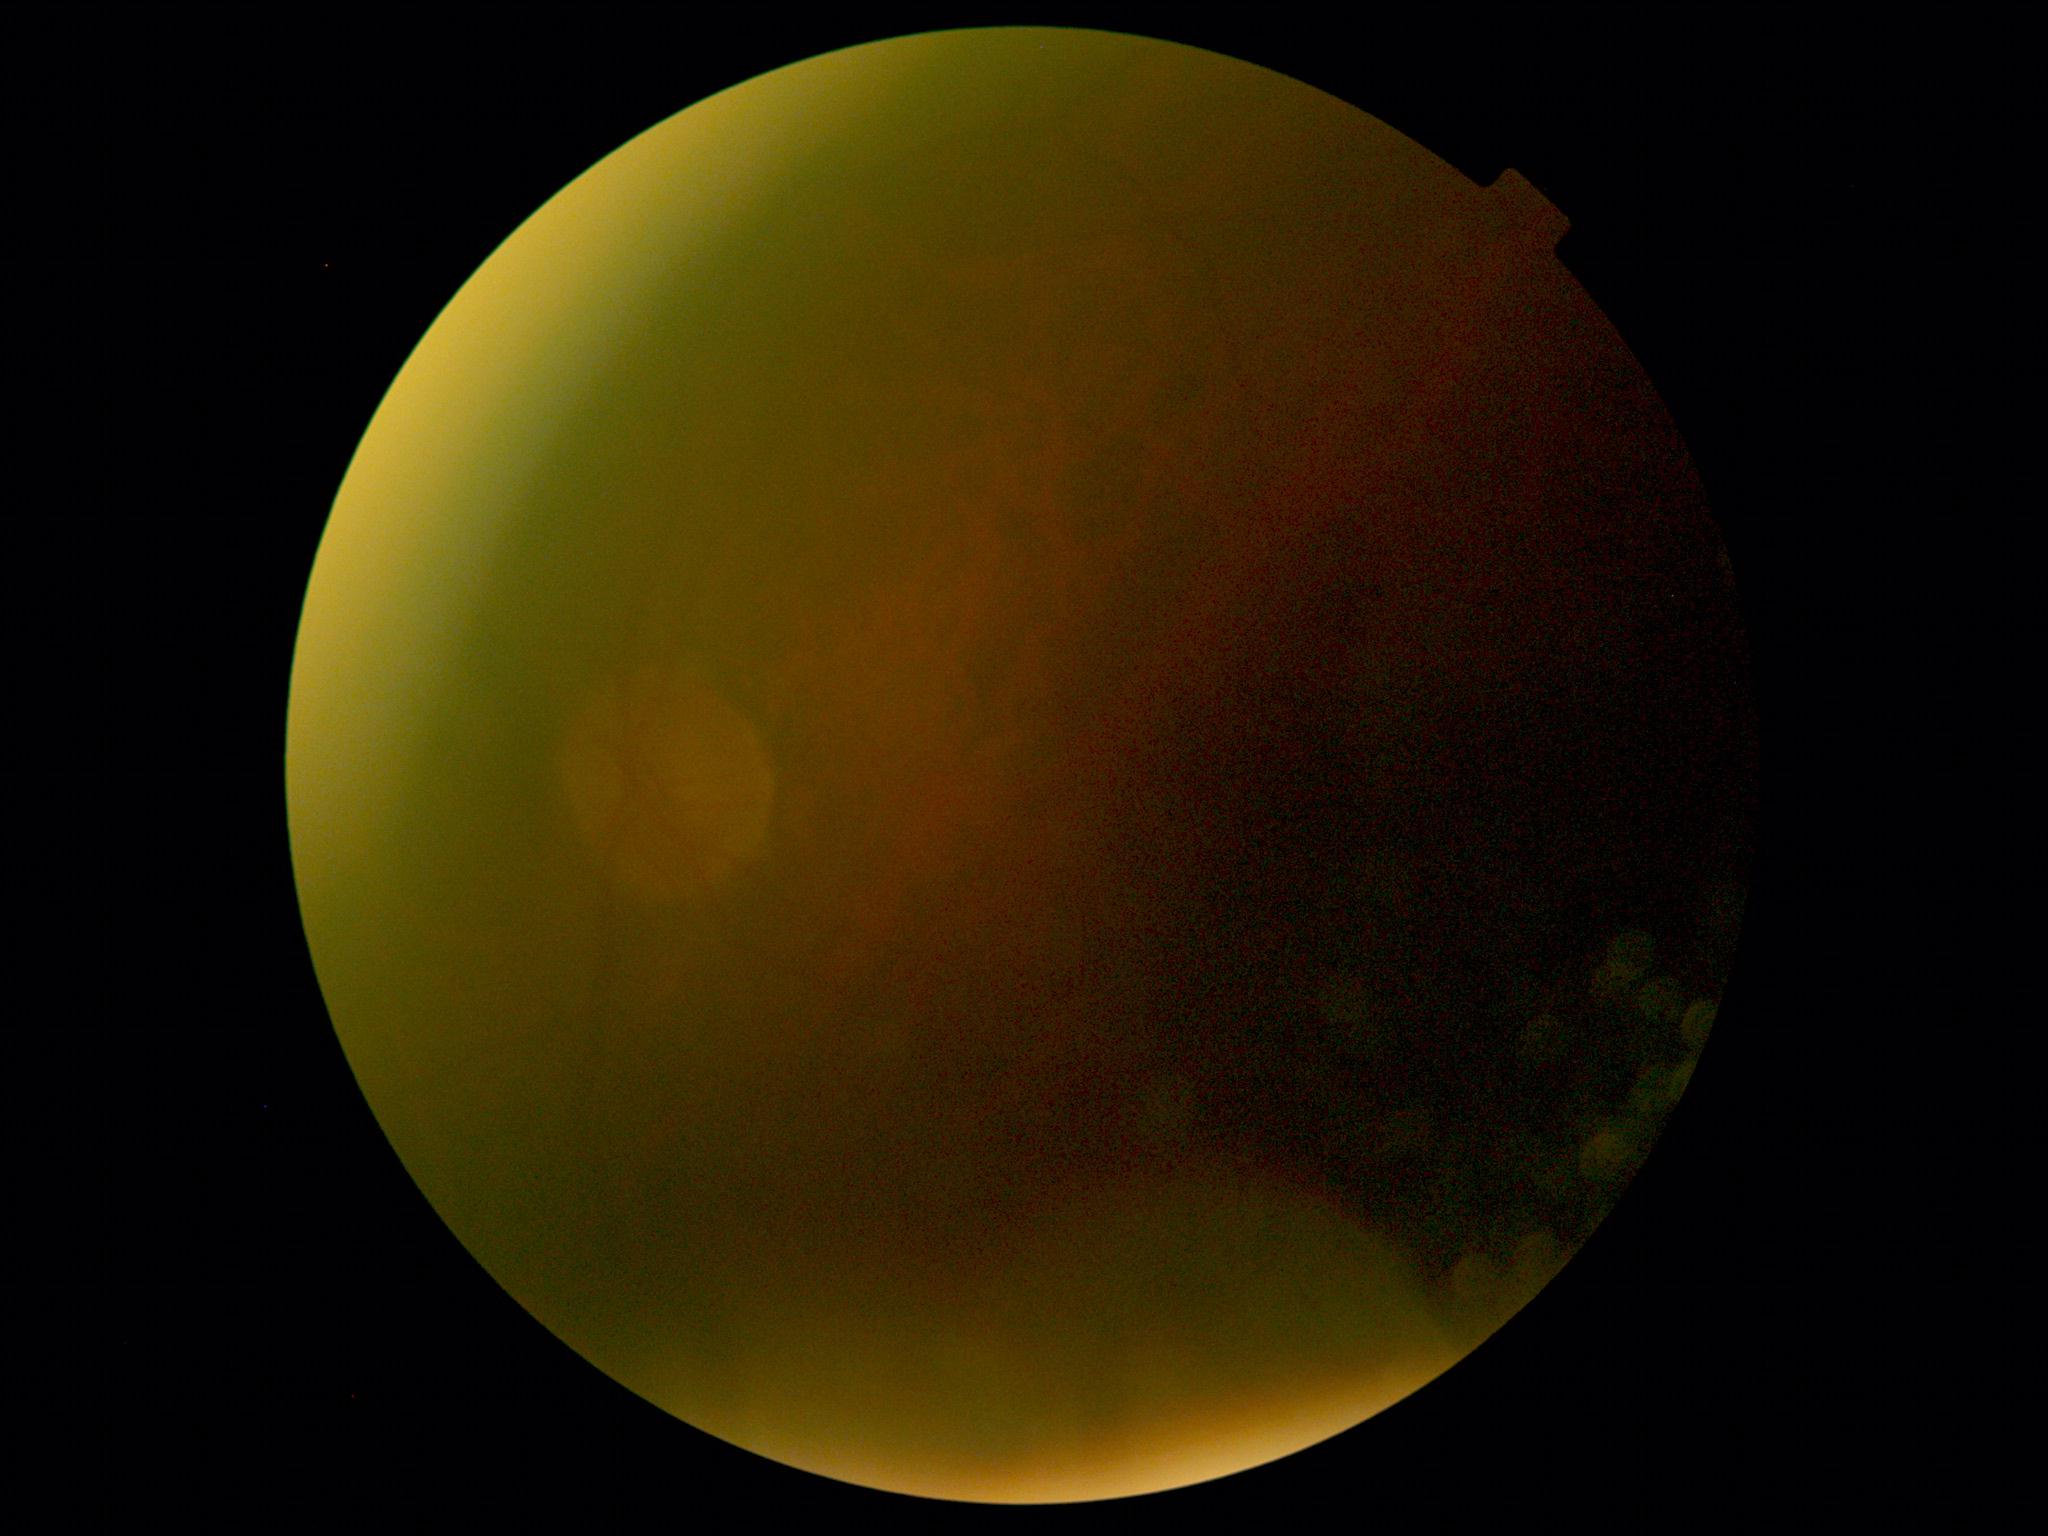

The image cannot be graded for diabetic retinopathy.
Diabetic retinopathy (DR) is ungradable due to poor image quality.